2352x1568px
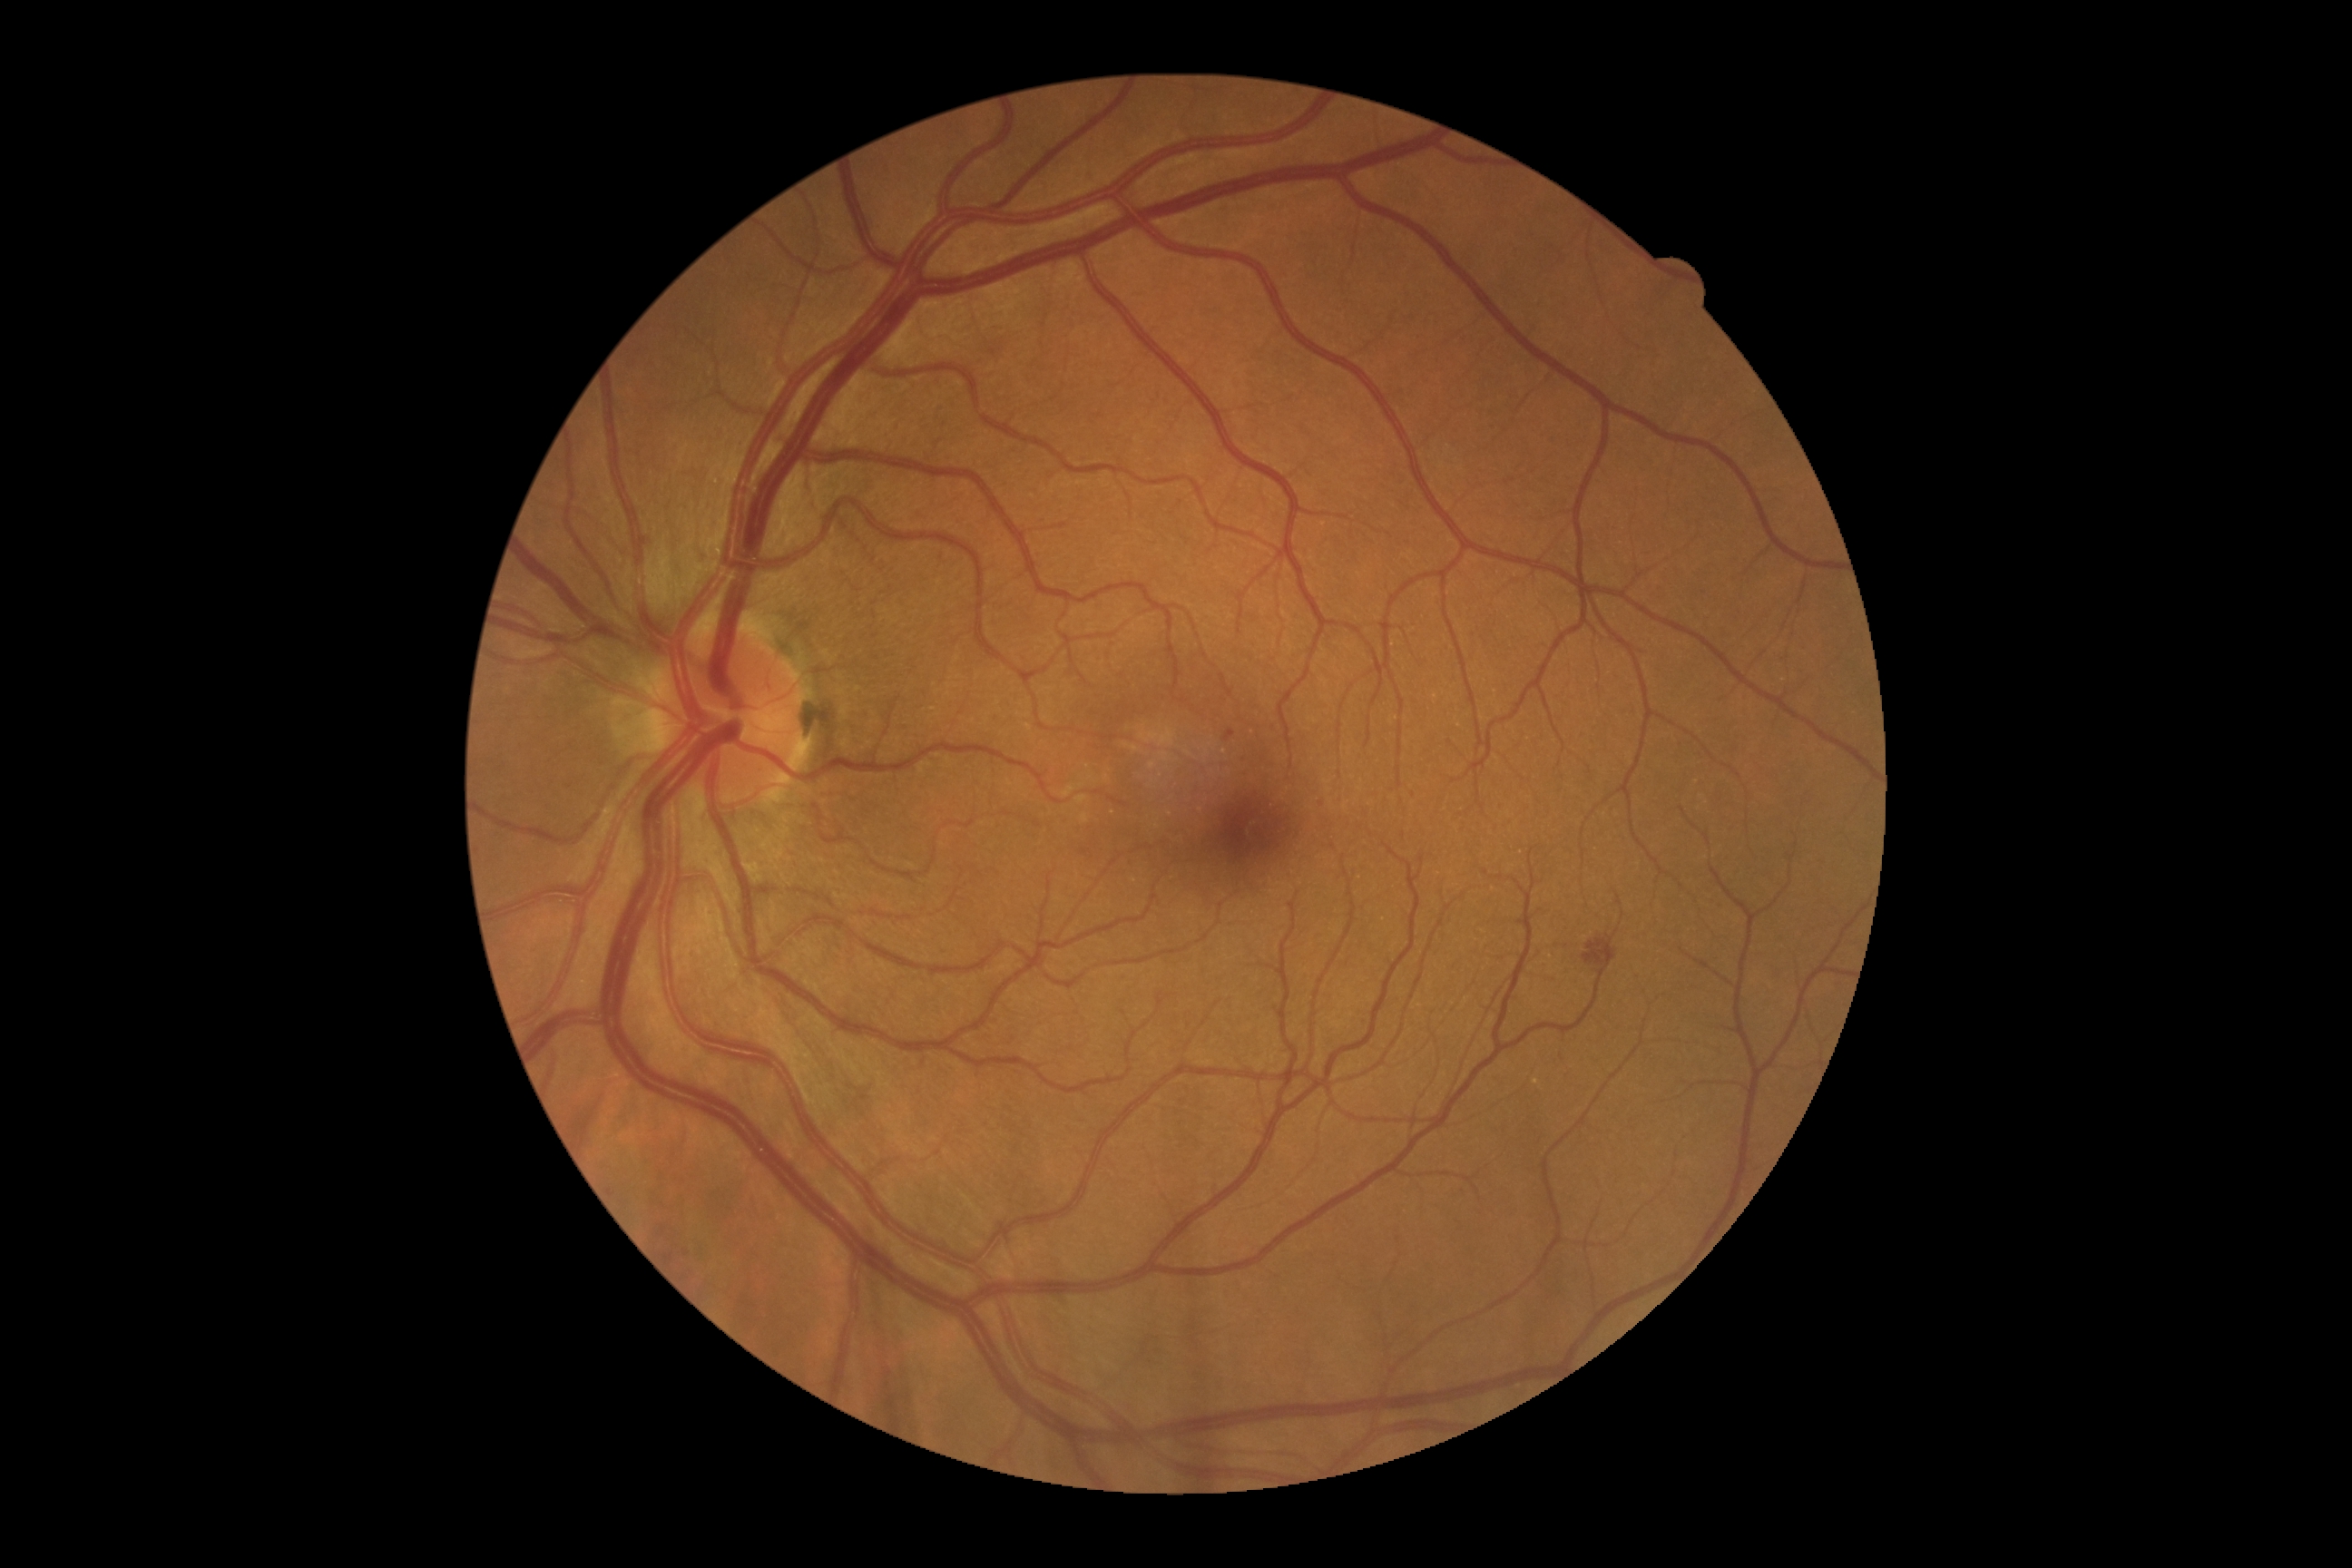
  dr_grade: moderate NPDR (2) — more than just microaneurysms but less than severe NPDR